NIDEK AFC-230; nonmydriatic fundus photograph:
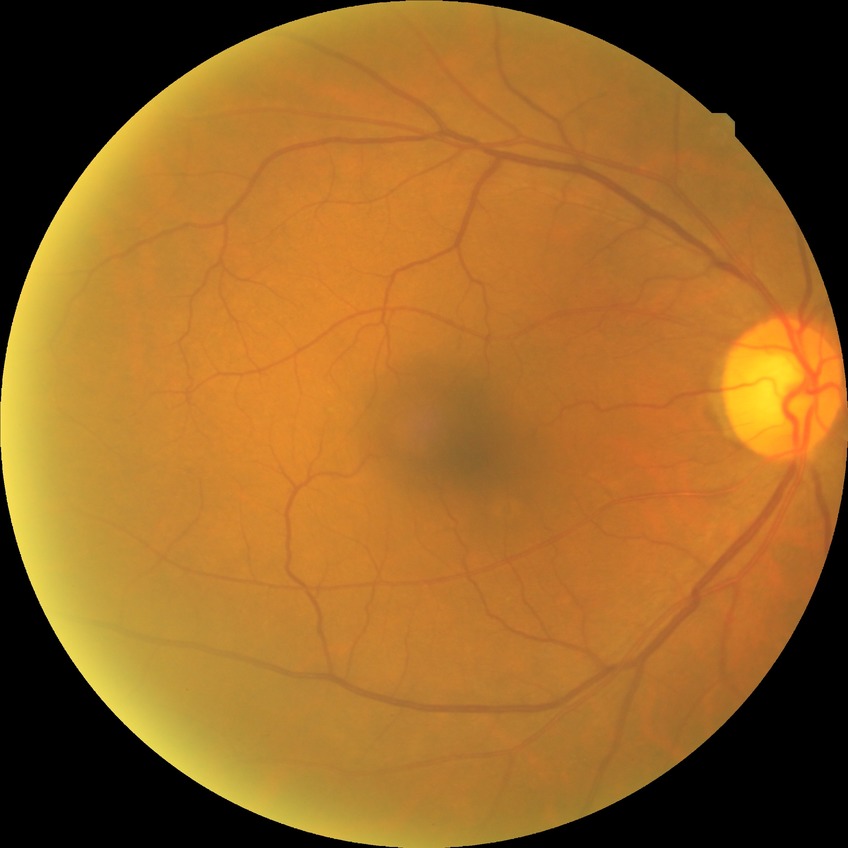
Diabetic retinopathy (DR) is NDR (no diabetic retinopathy).